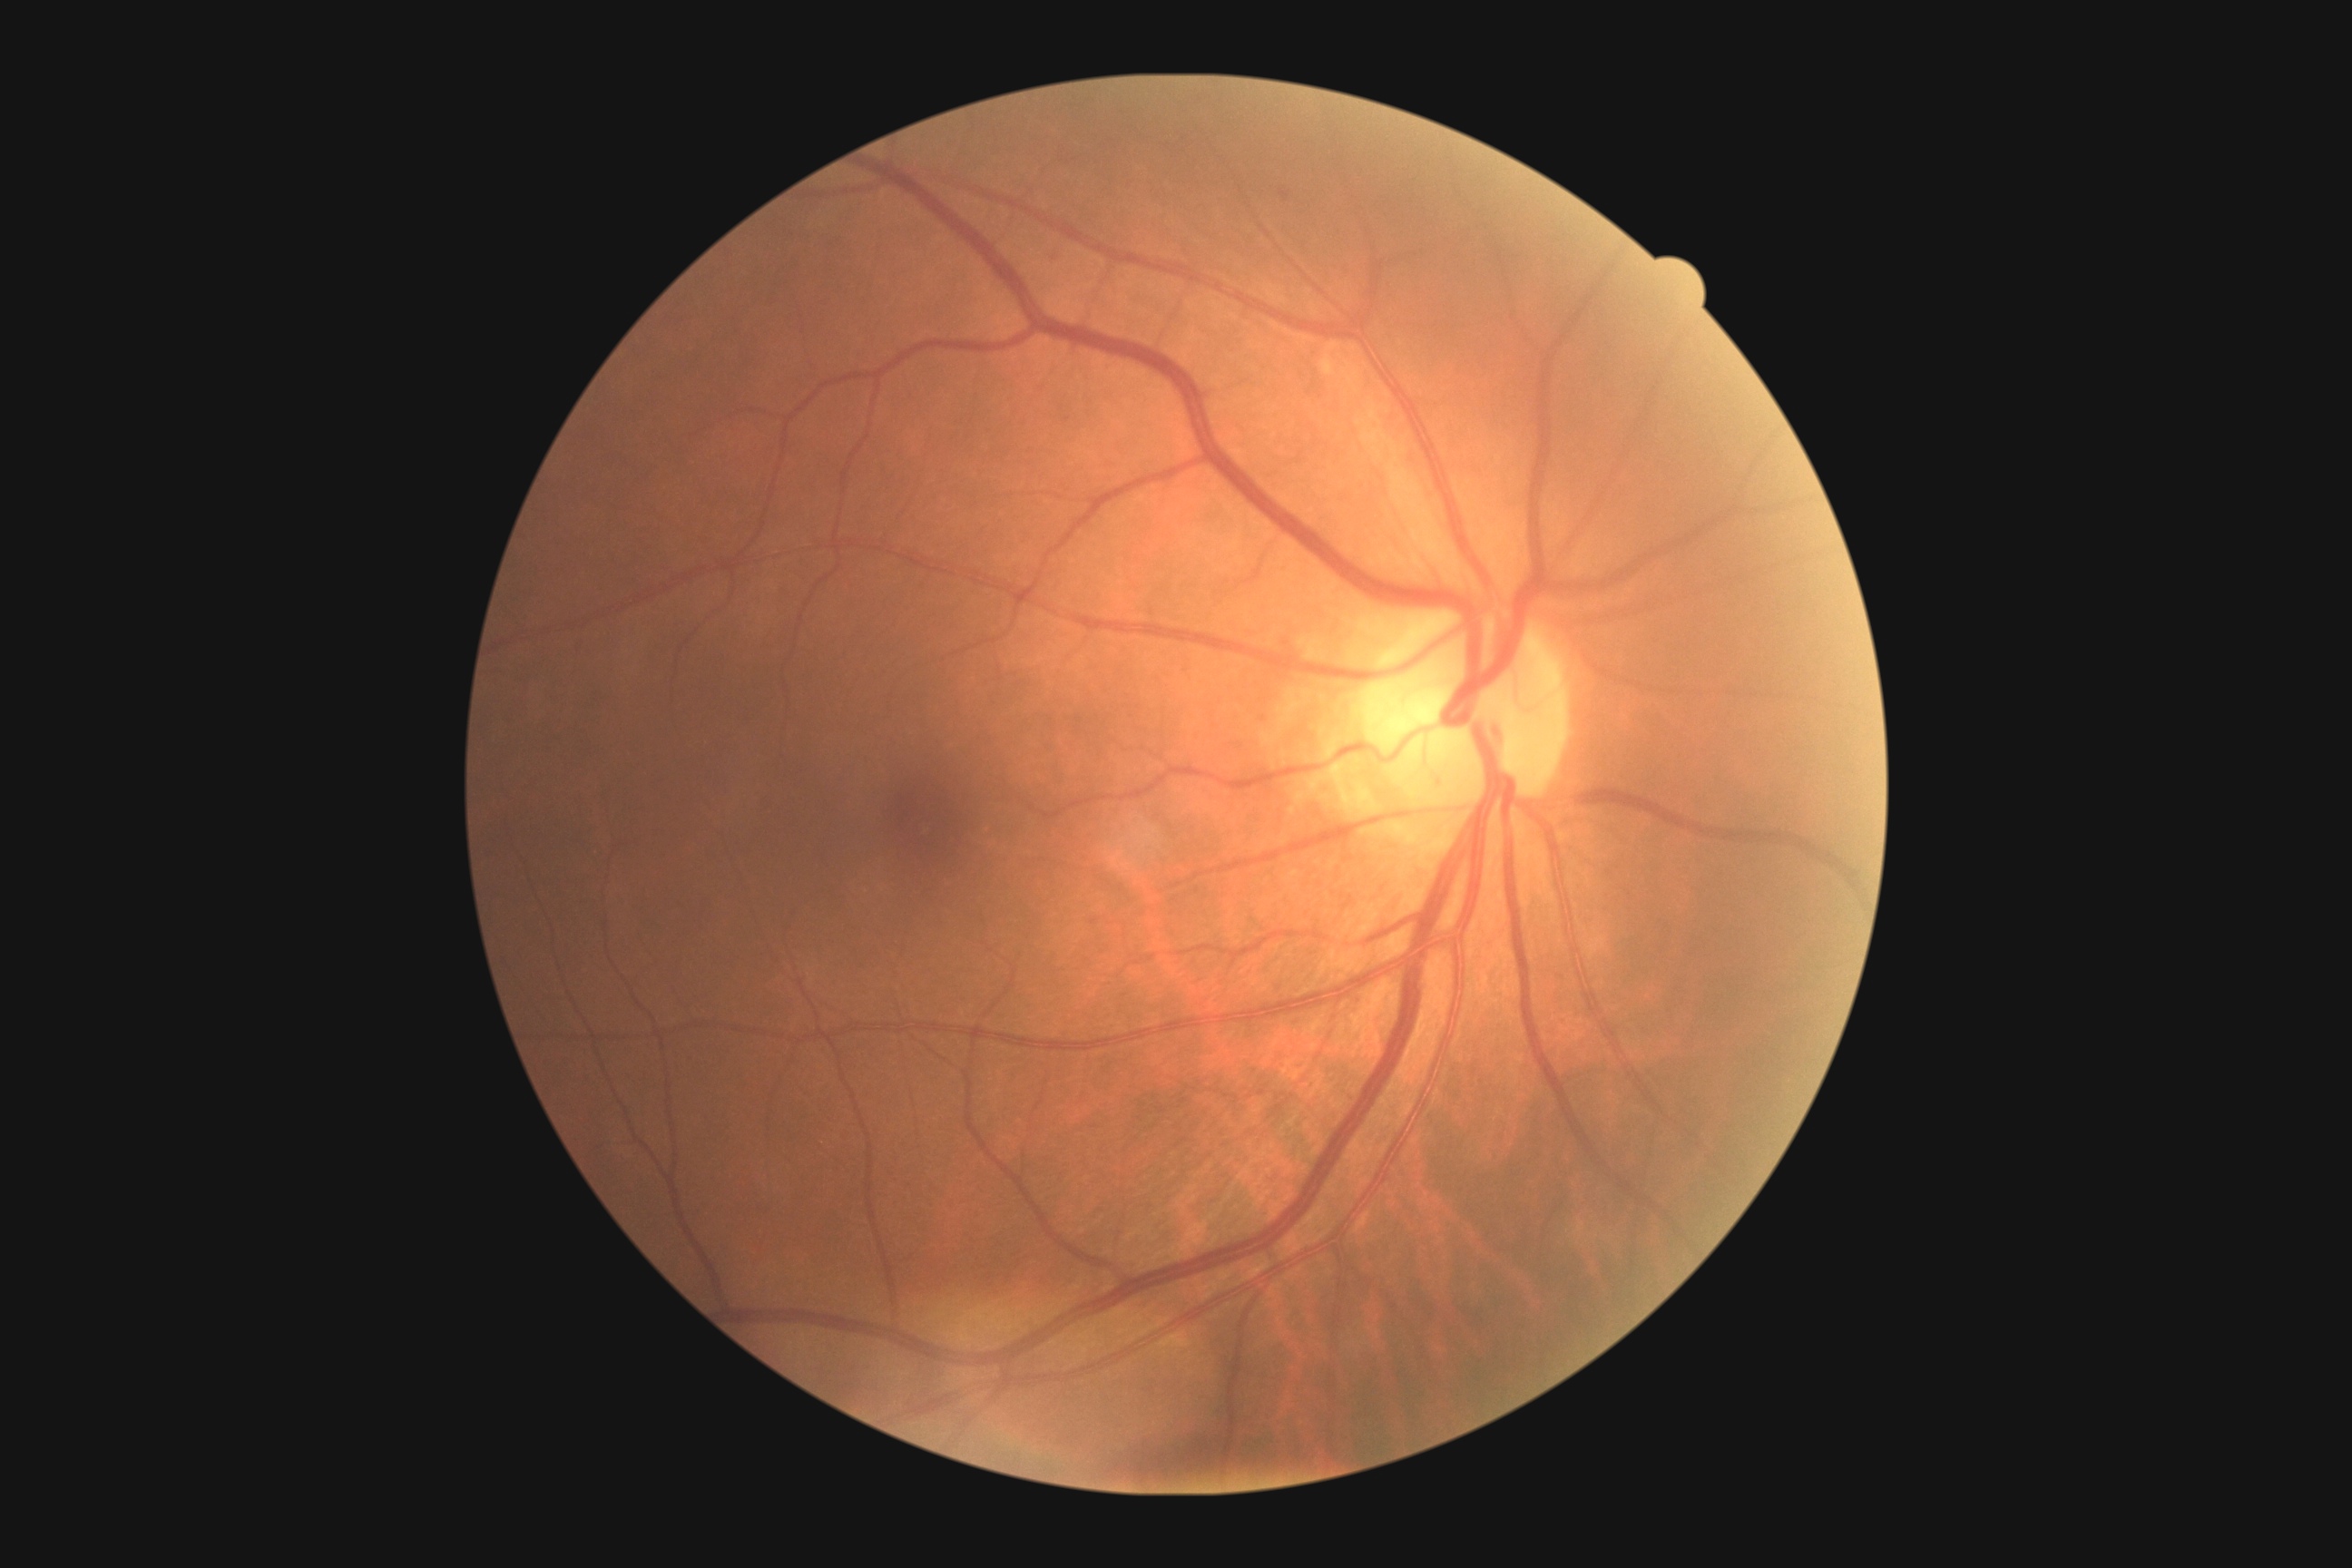 DR grade is 1 — presence of microaneurysms only.